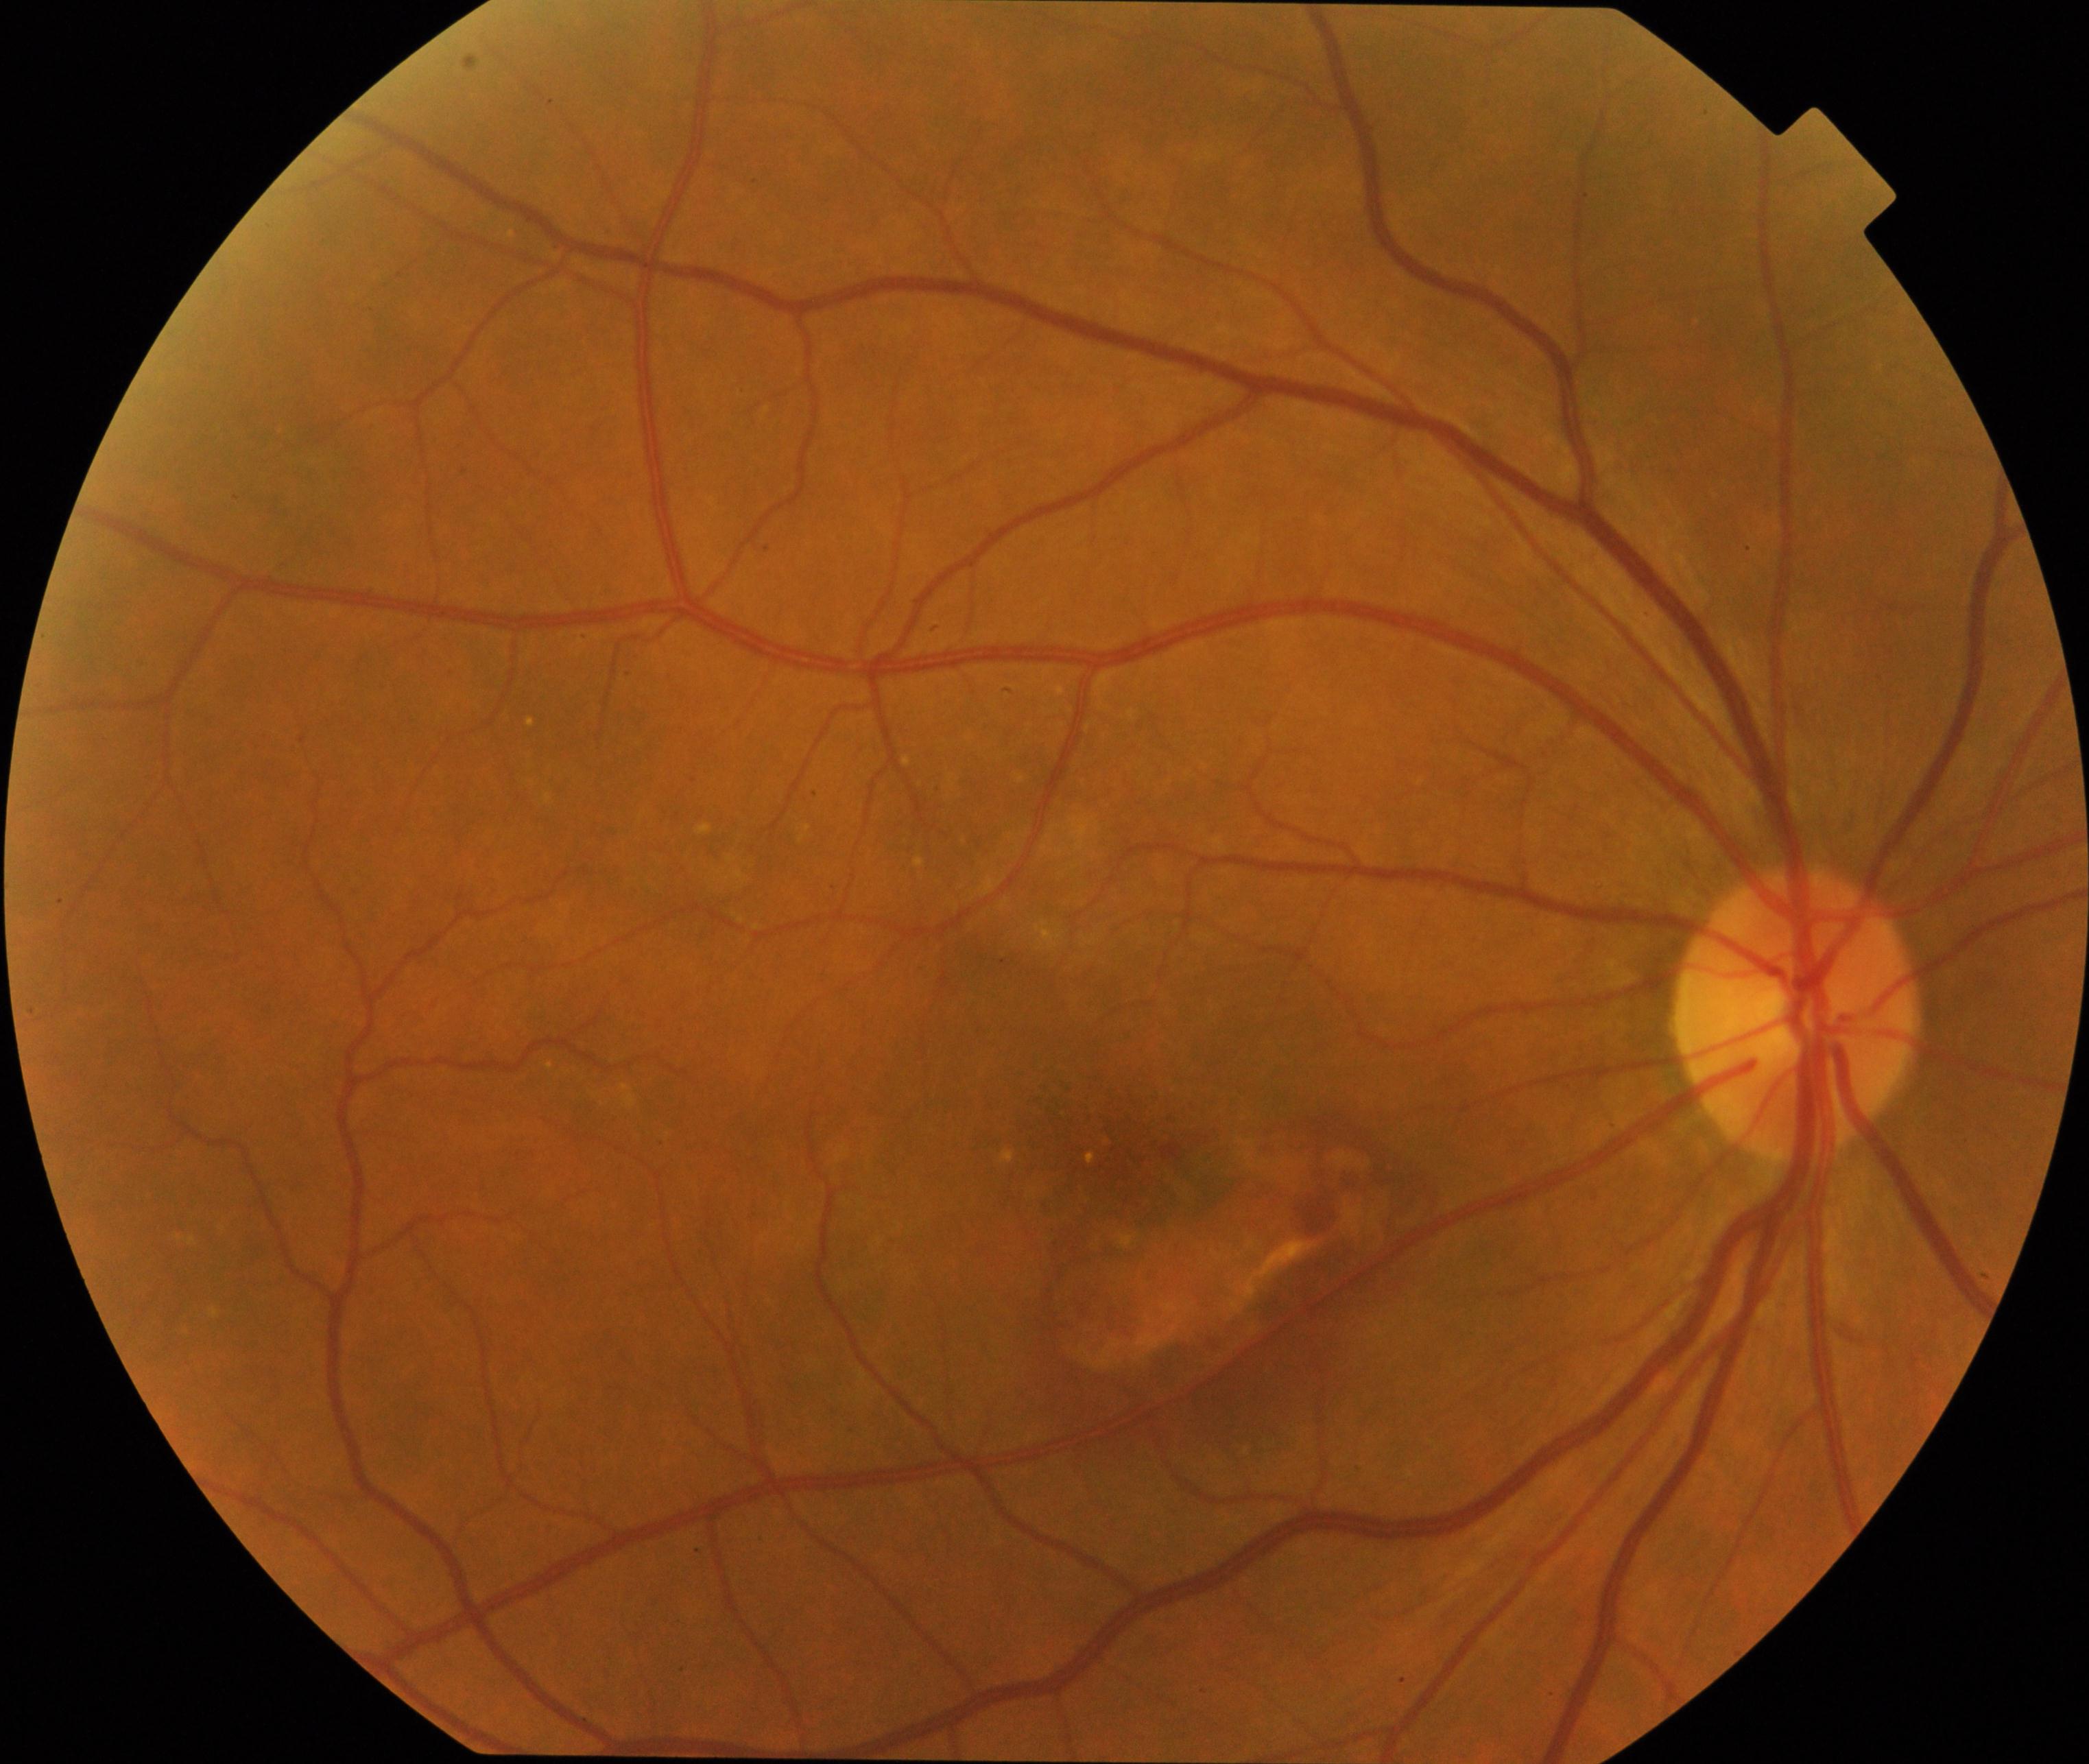
Classification: maculopathy.